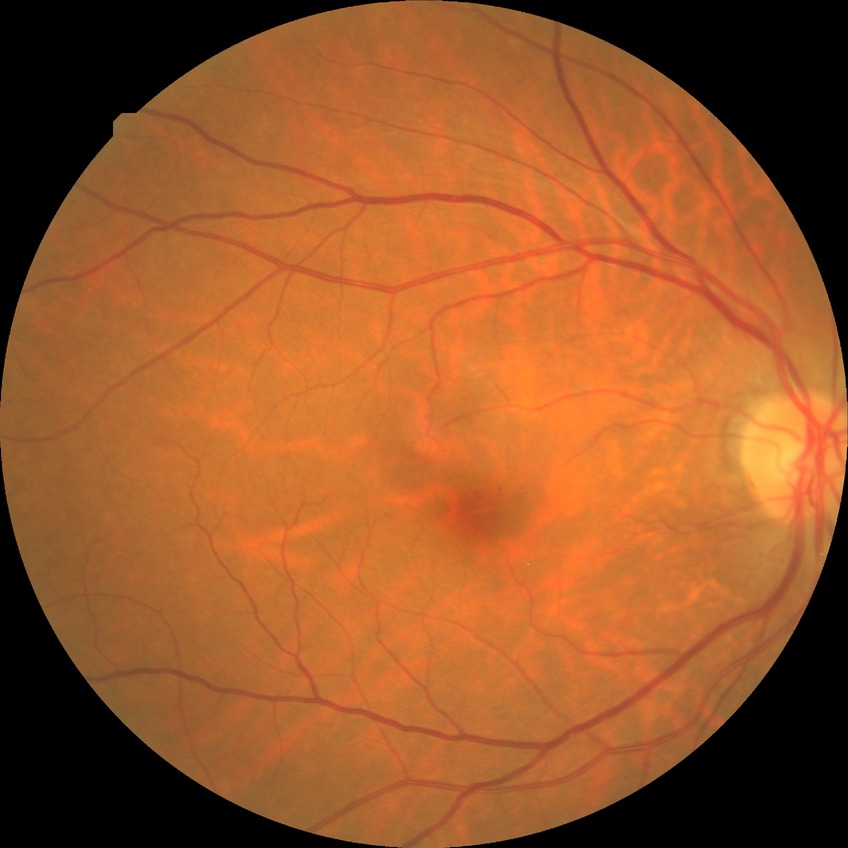
Davis grading is no diabetic retinopathy.